FOV: 50 degrees. Fundus photo: 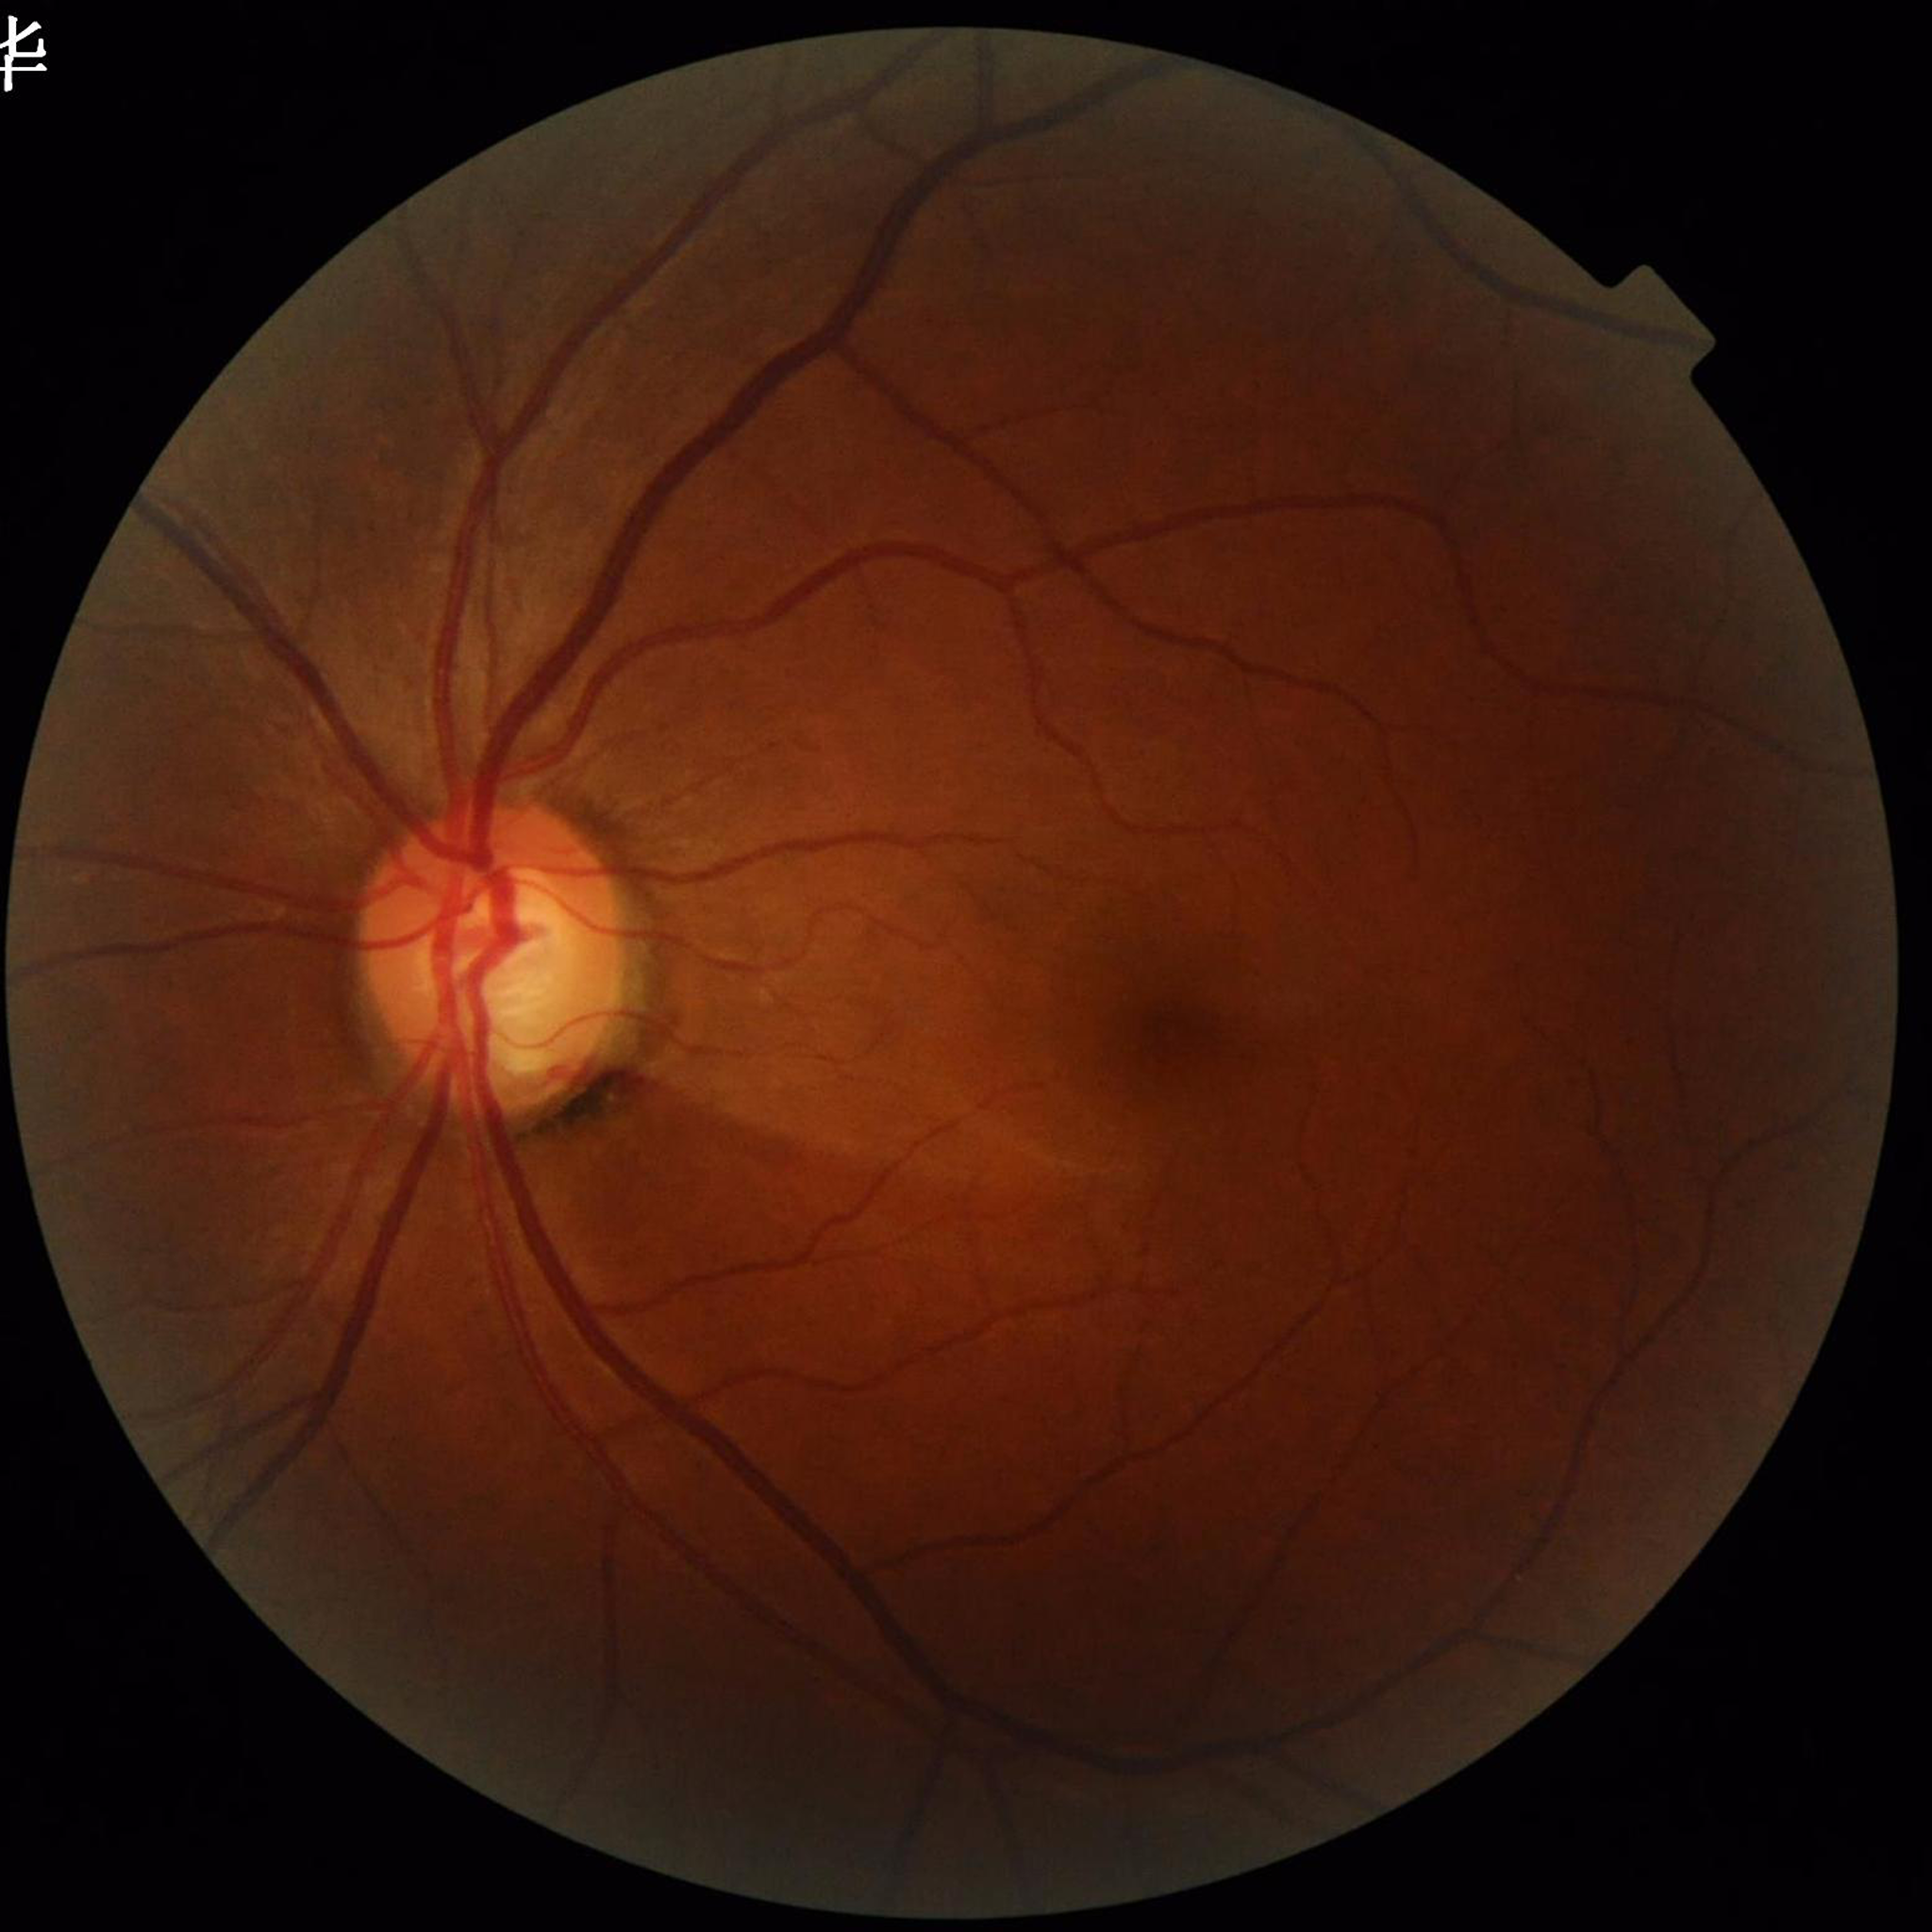 Disease: glaucoma | Photo quality: reduced — illumination/color distortion.